Pediatric wide-field fundus photograph. Captured with the Phoenix ICON (100° field of view) — 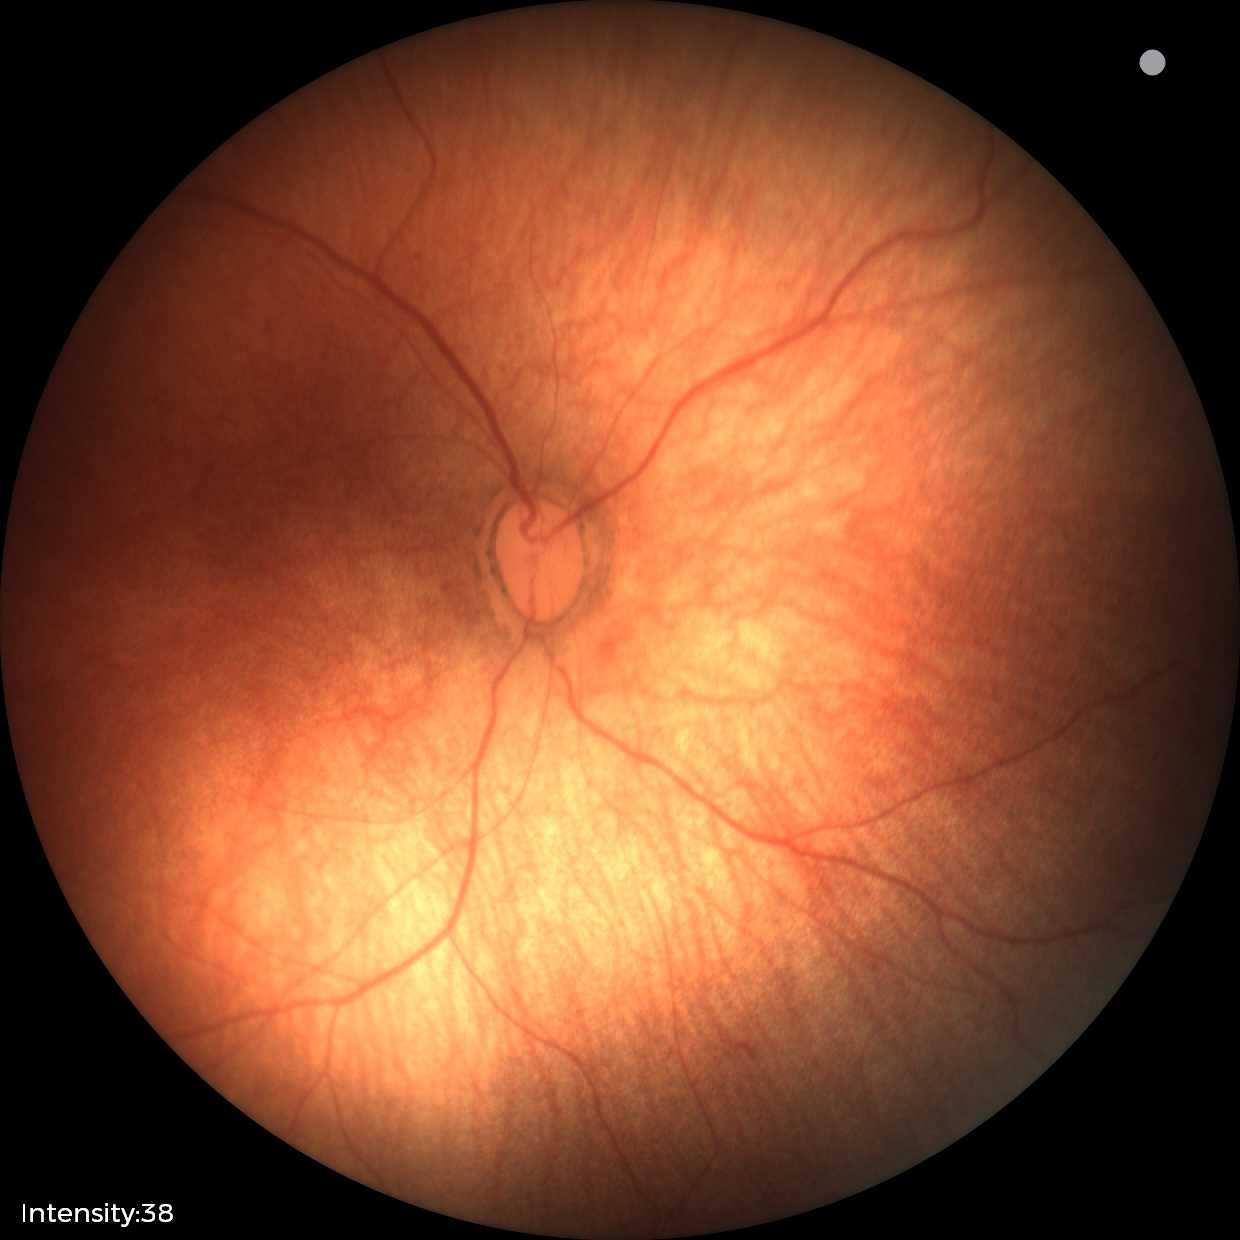 Screening diagnosis: physiological finding.